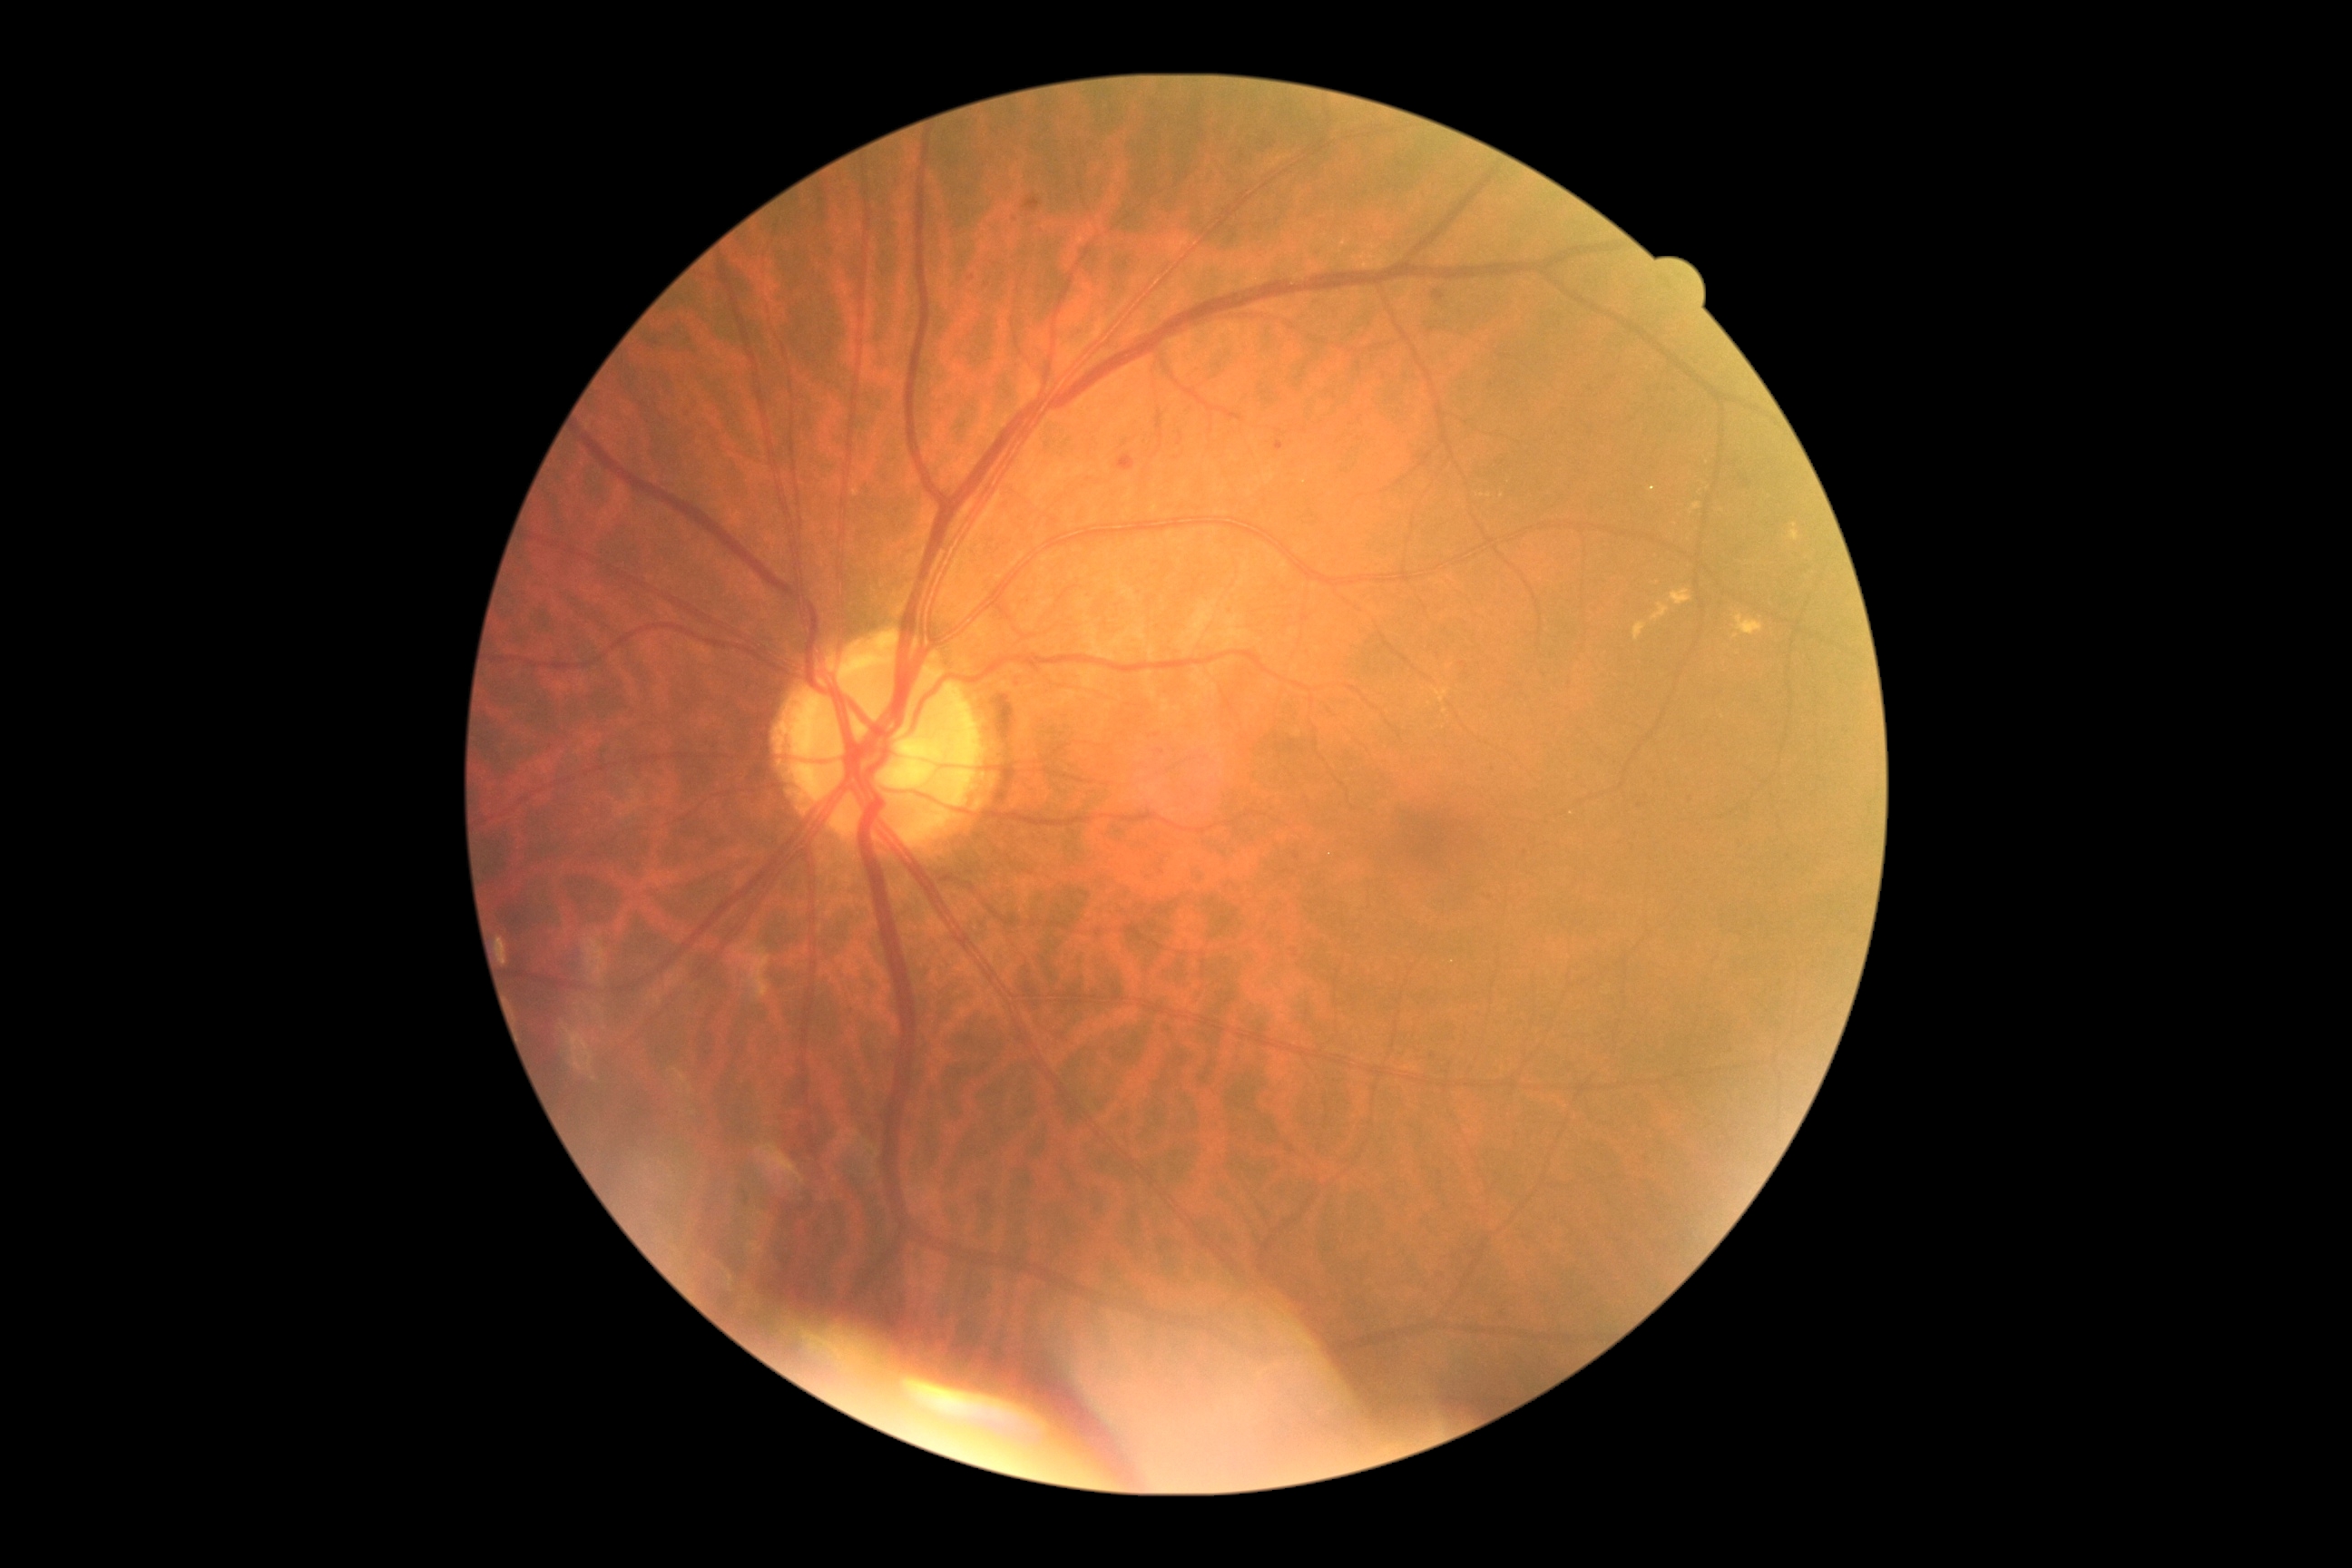
DR is grade 2 (moderate NPDR) — more than just microaneurysms but less than severe NPDR.